Wide-field fundus photograph of an infant · Clarity RetCam 3, 130° FOV:
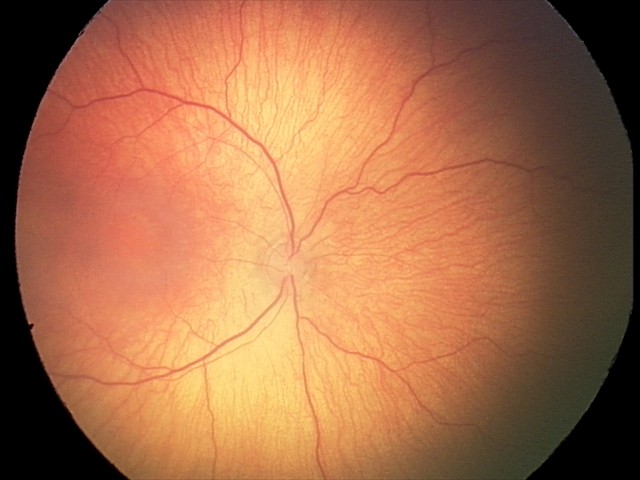

Without plus disease. Examination diagnosed as ROP stage 1.